Color fundus photograph: 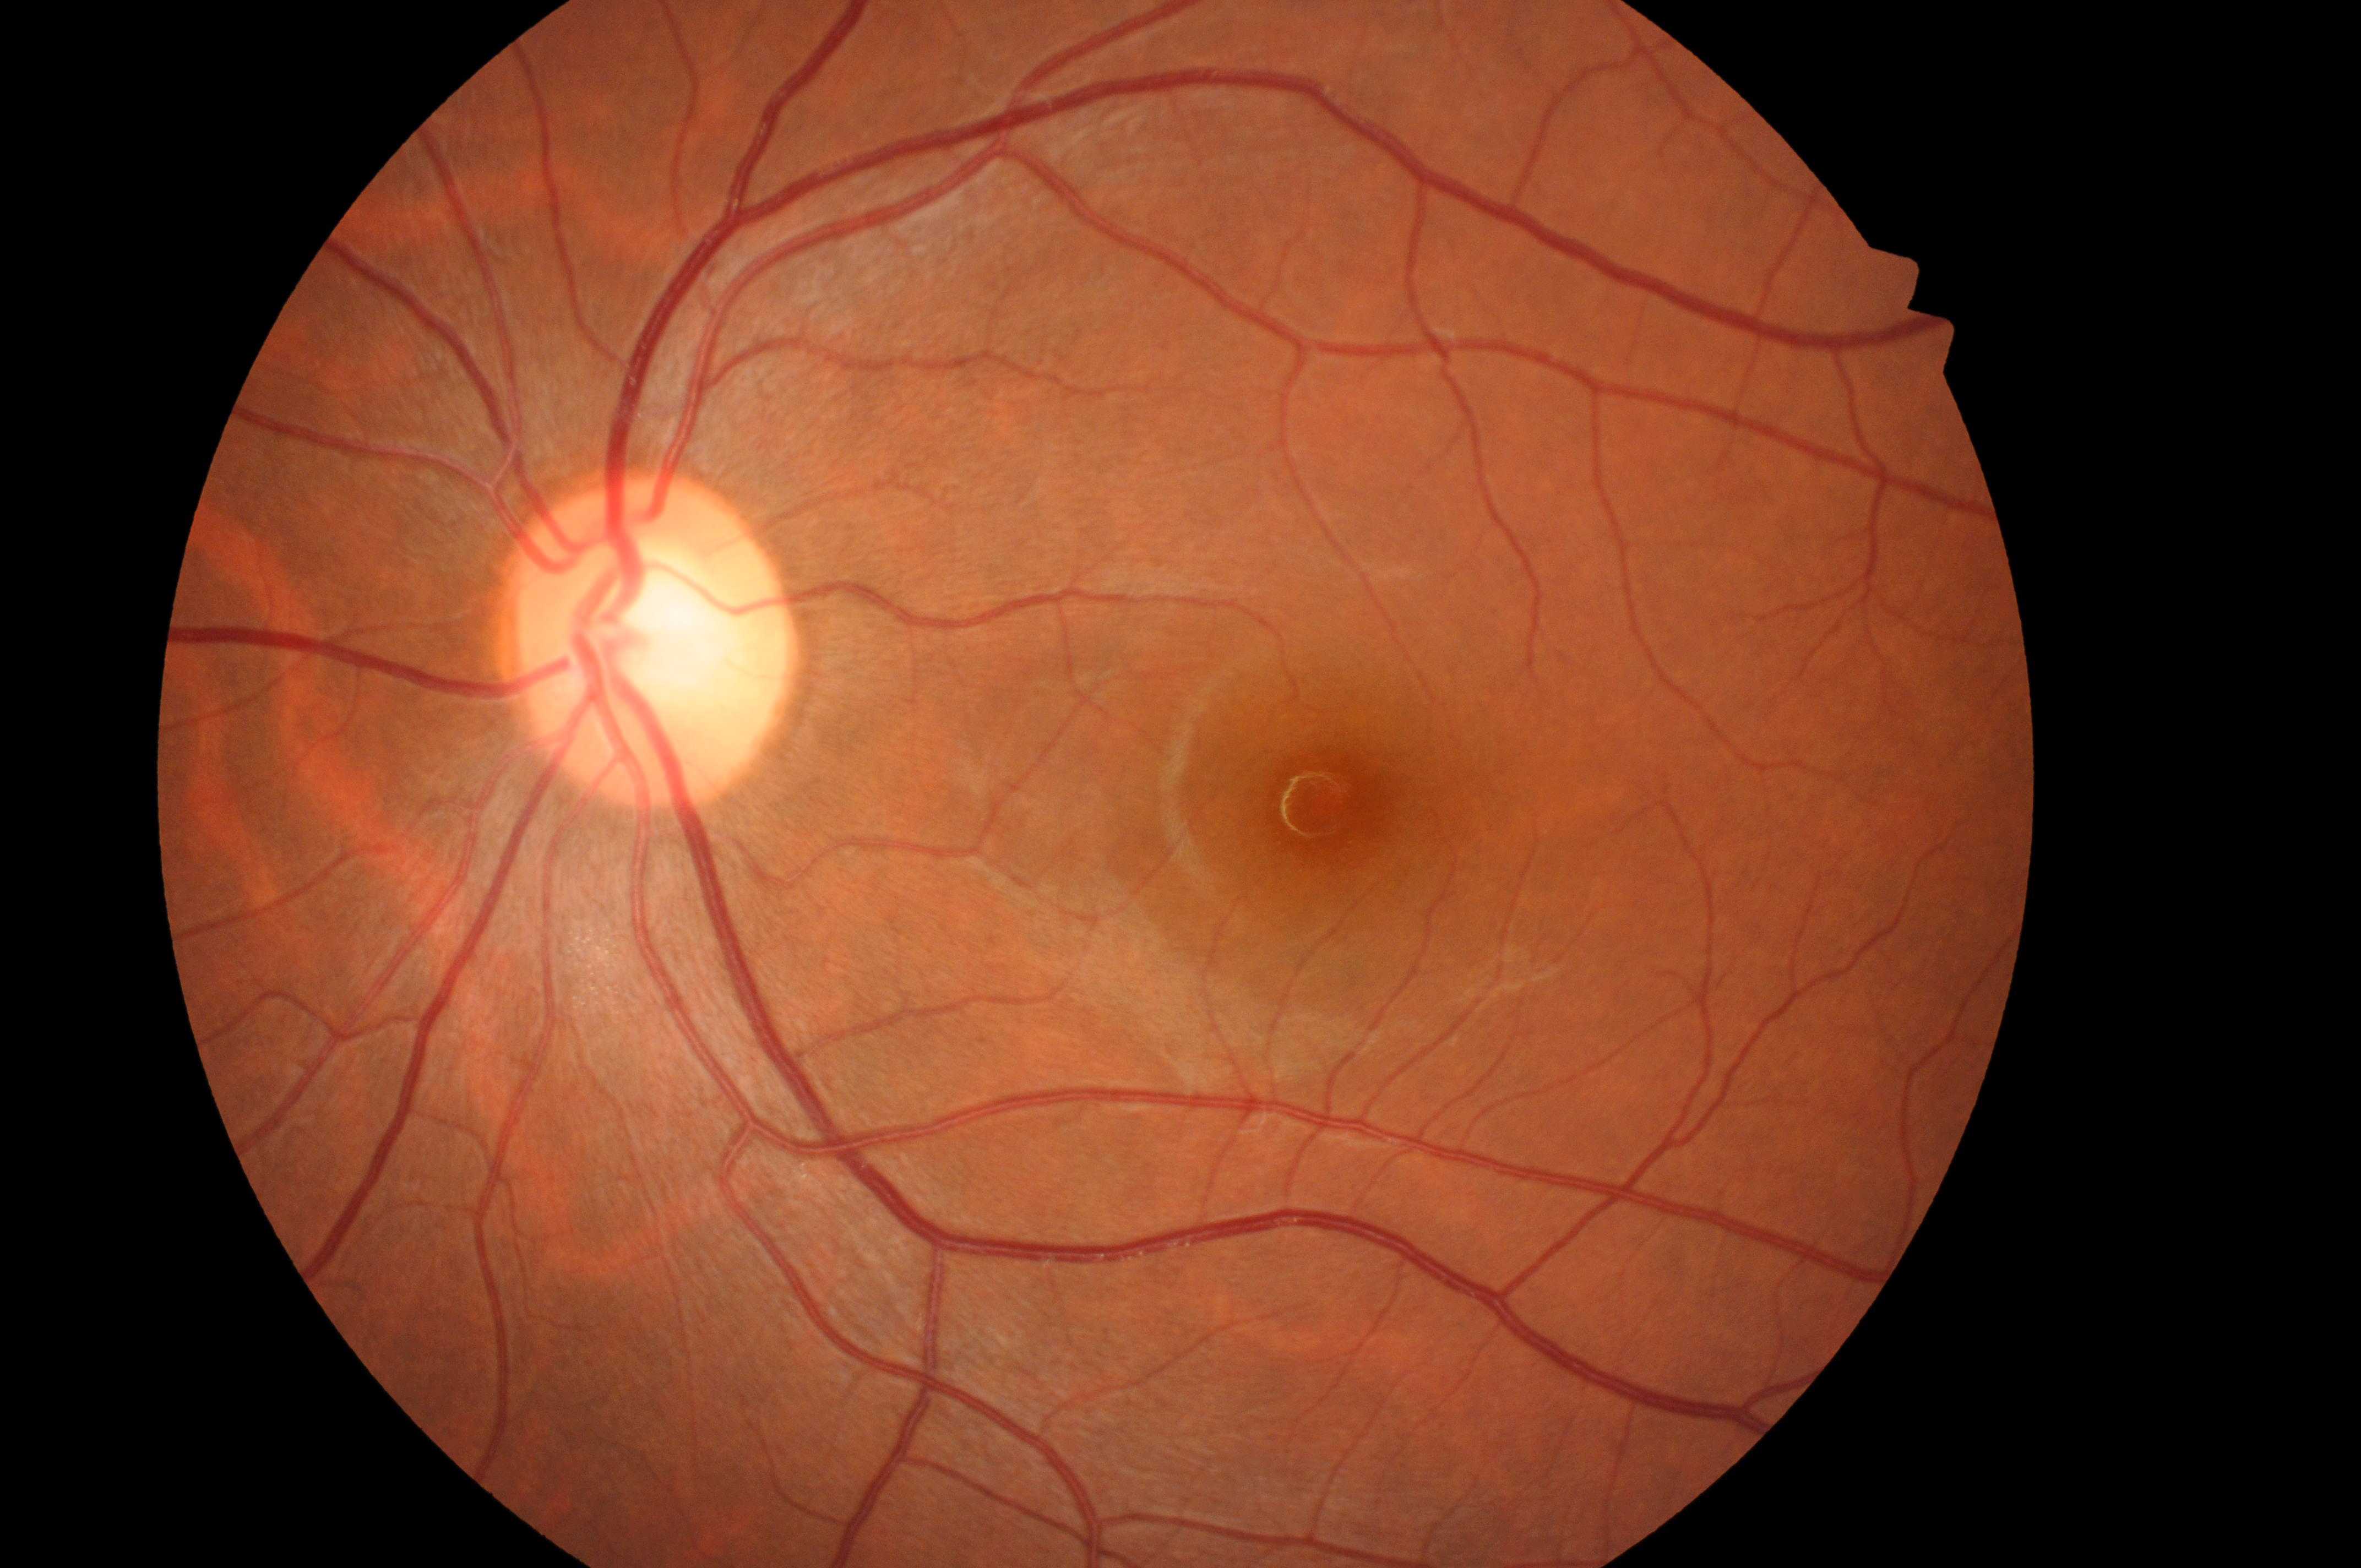 macula center = x=1341, y=812; optic disc = x=637, y=654; laterality = oculus sinister; DME grade = no risk (0); DR = no apparent diabetic retinopathy (grade 0).